Color fundus photograph; Kowa VX-10α
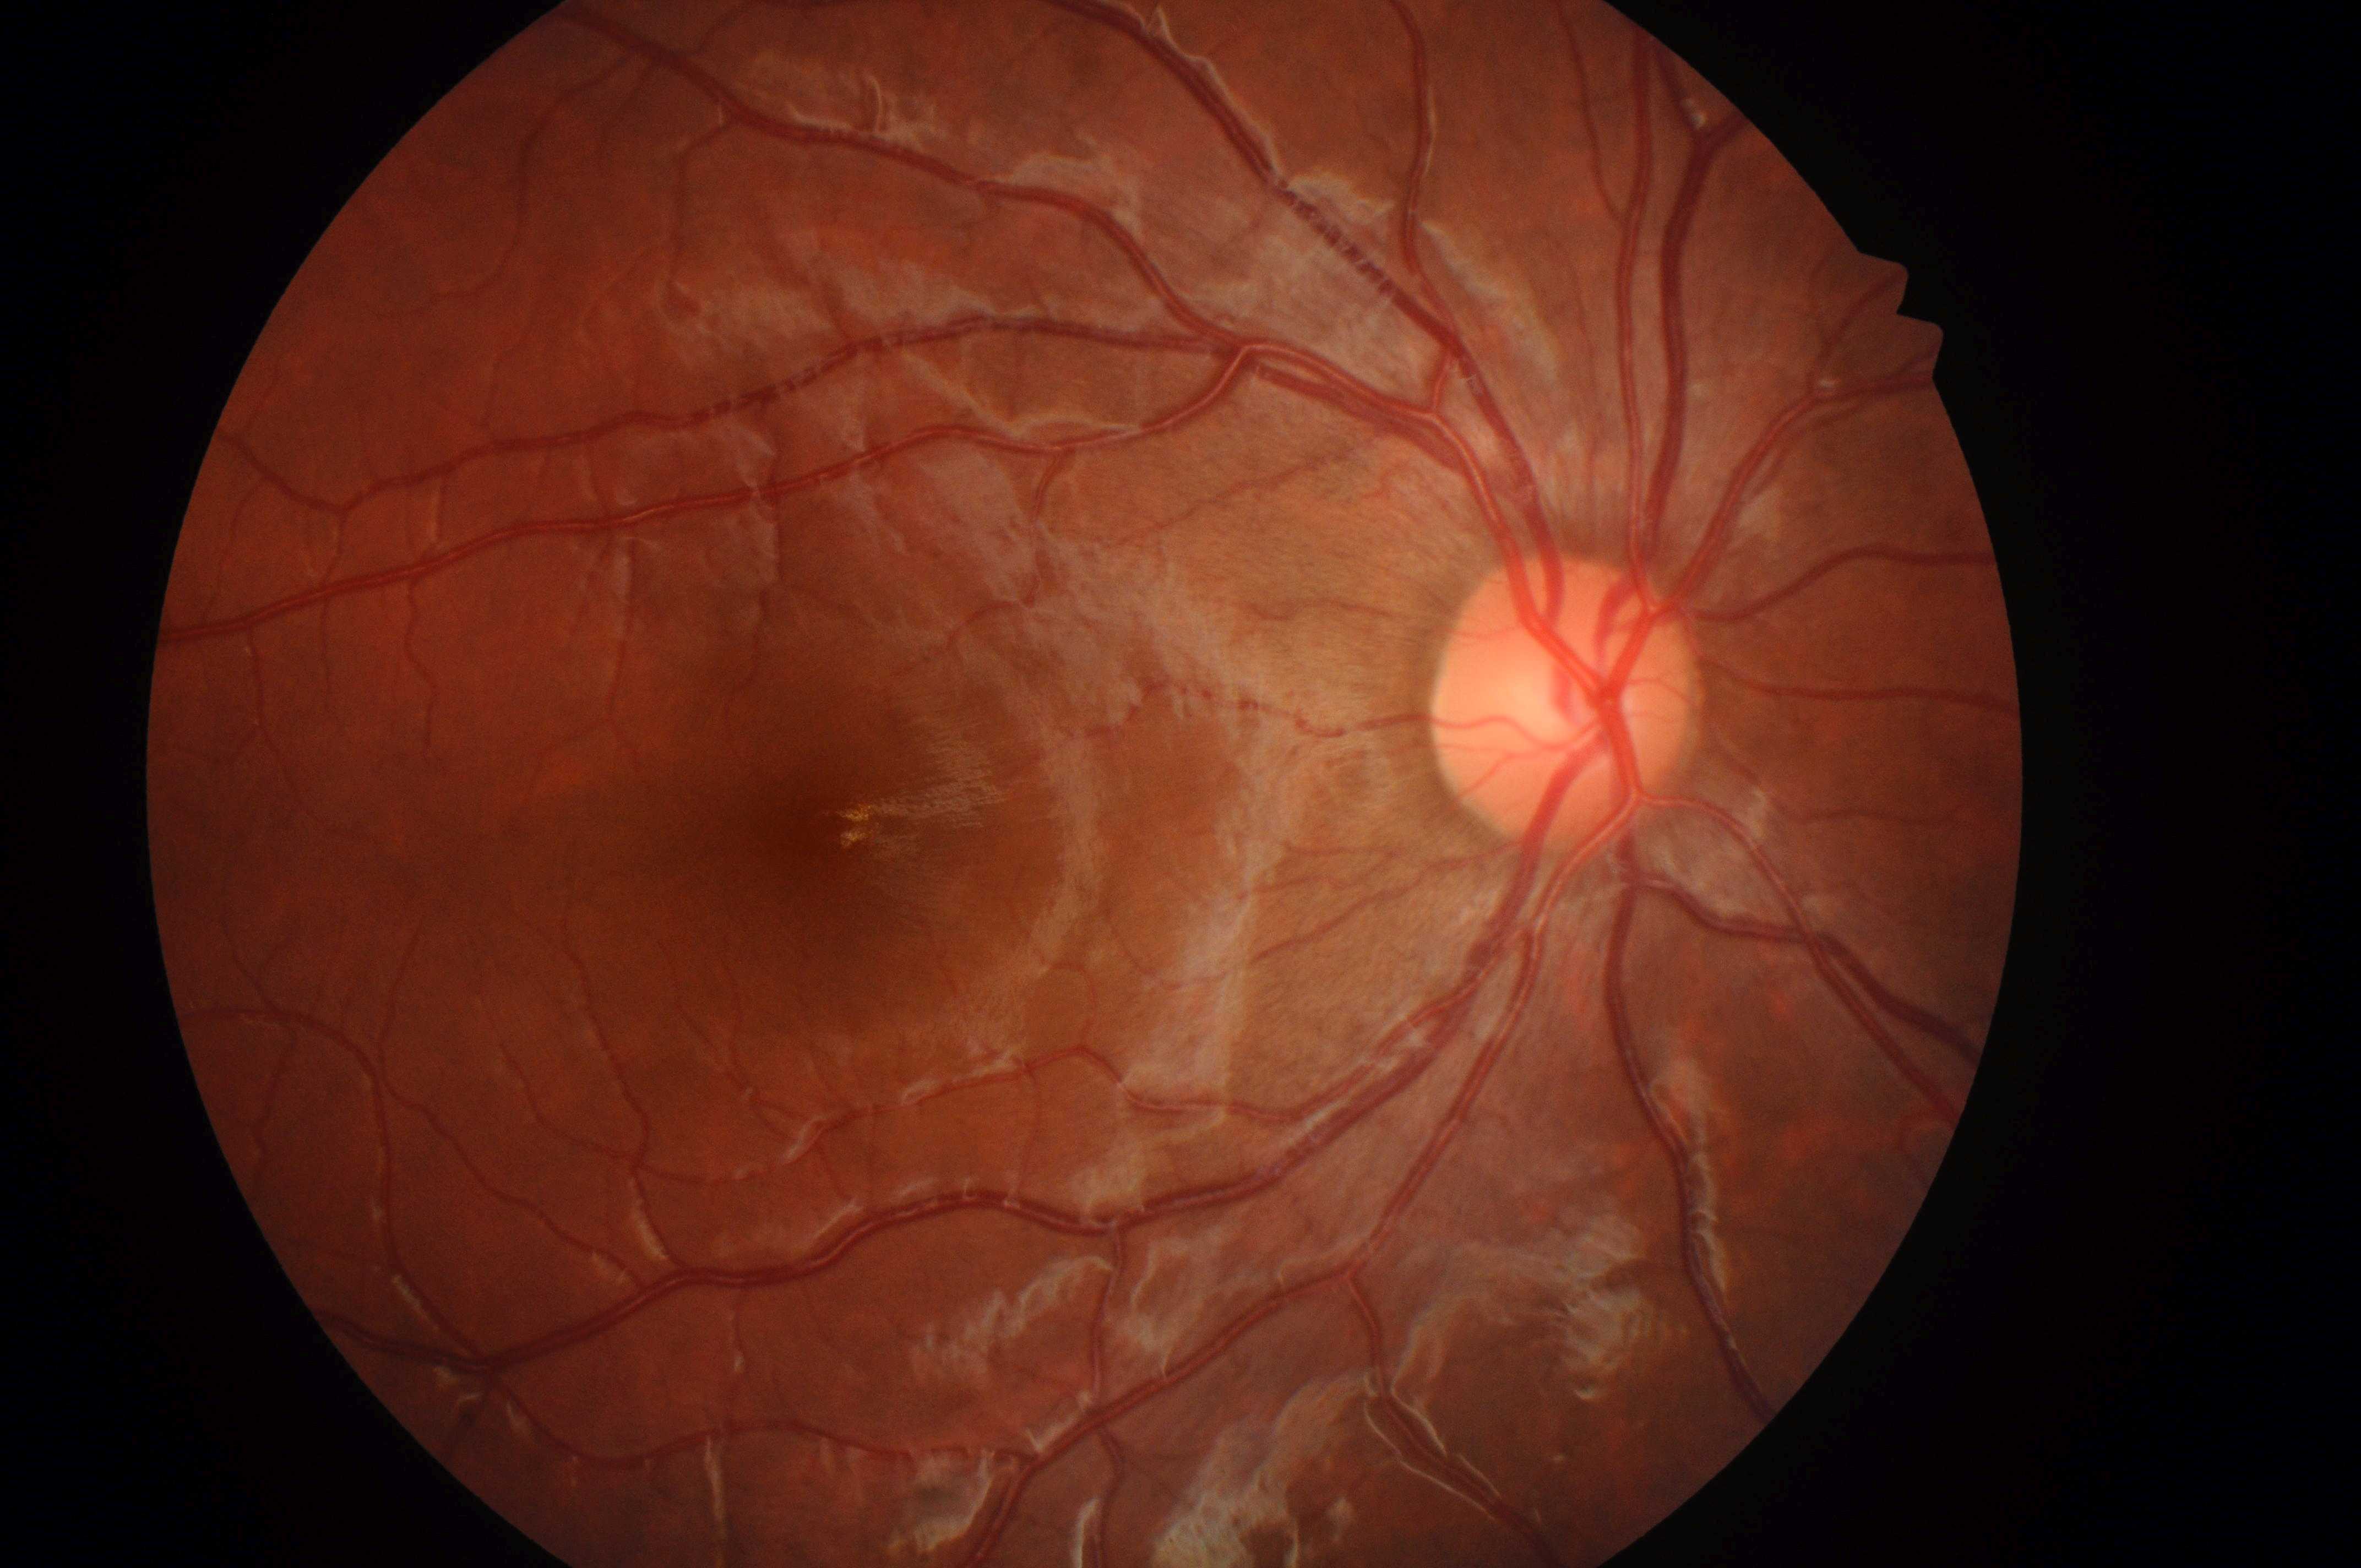

macular edema=no risk (grade 0) | retinopathy=no apparent retinopathy (grade 0) | optic disc center=x=1557, y=713 | the right eye | macular center=x=835, y=831.